CFP — 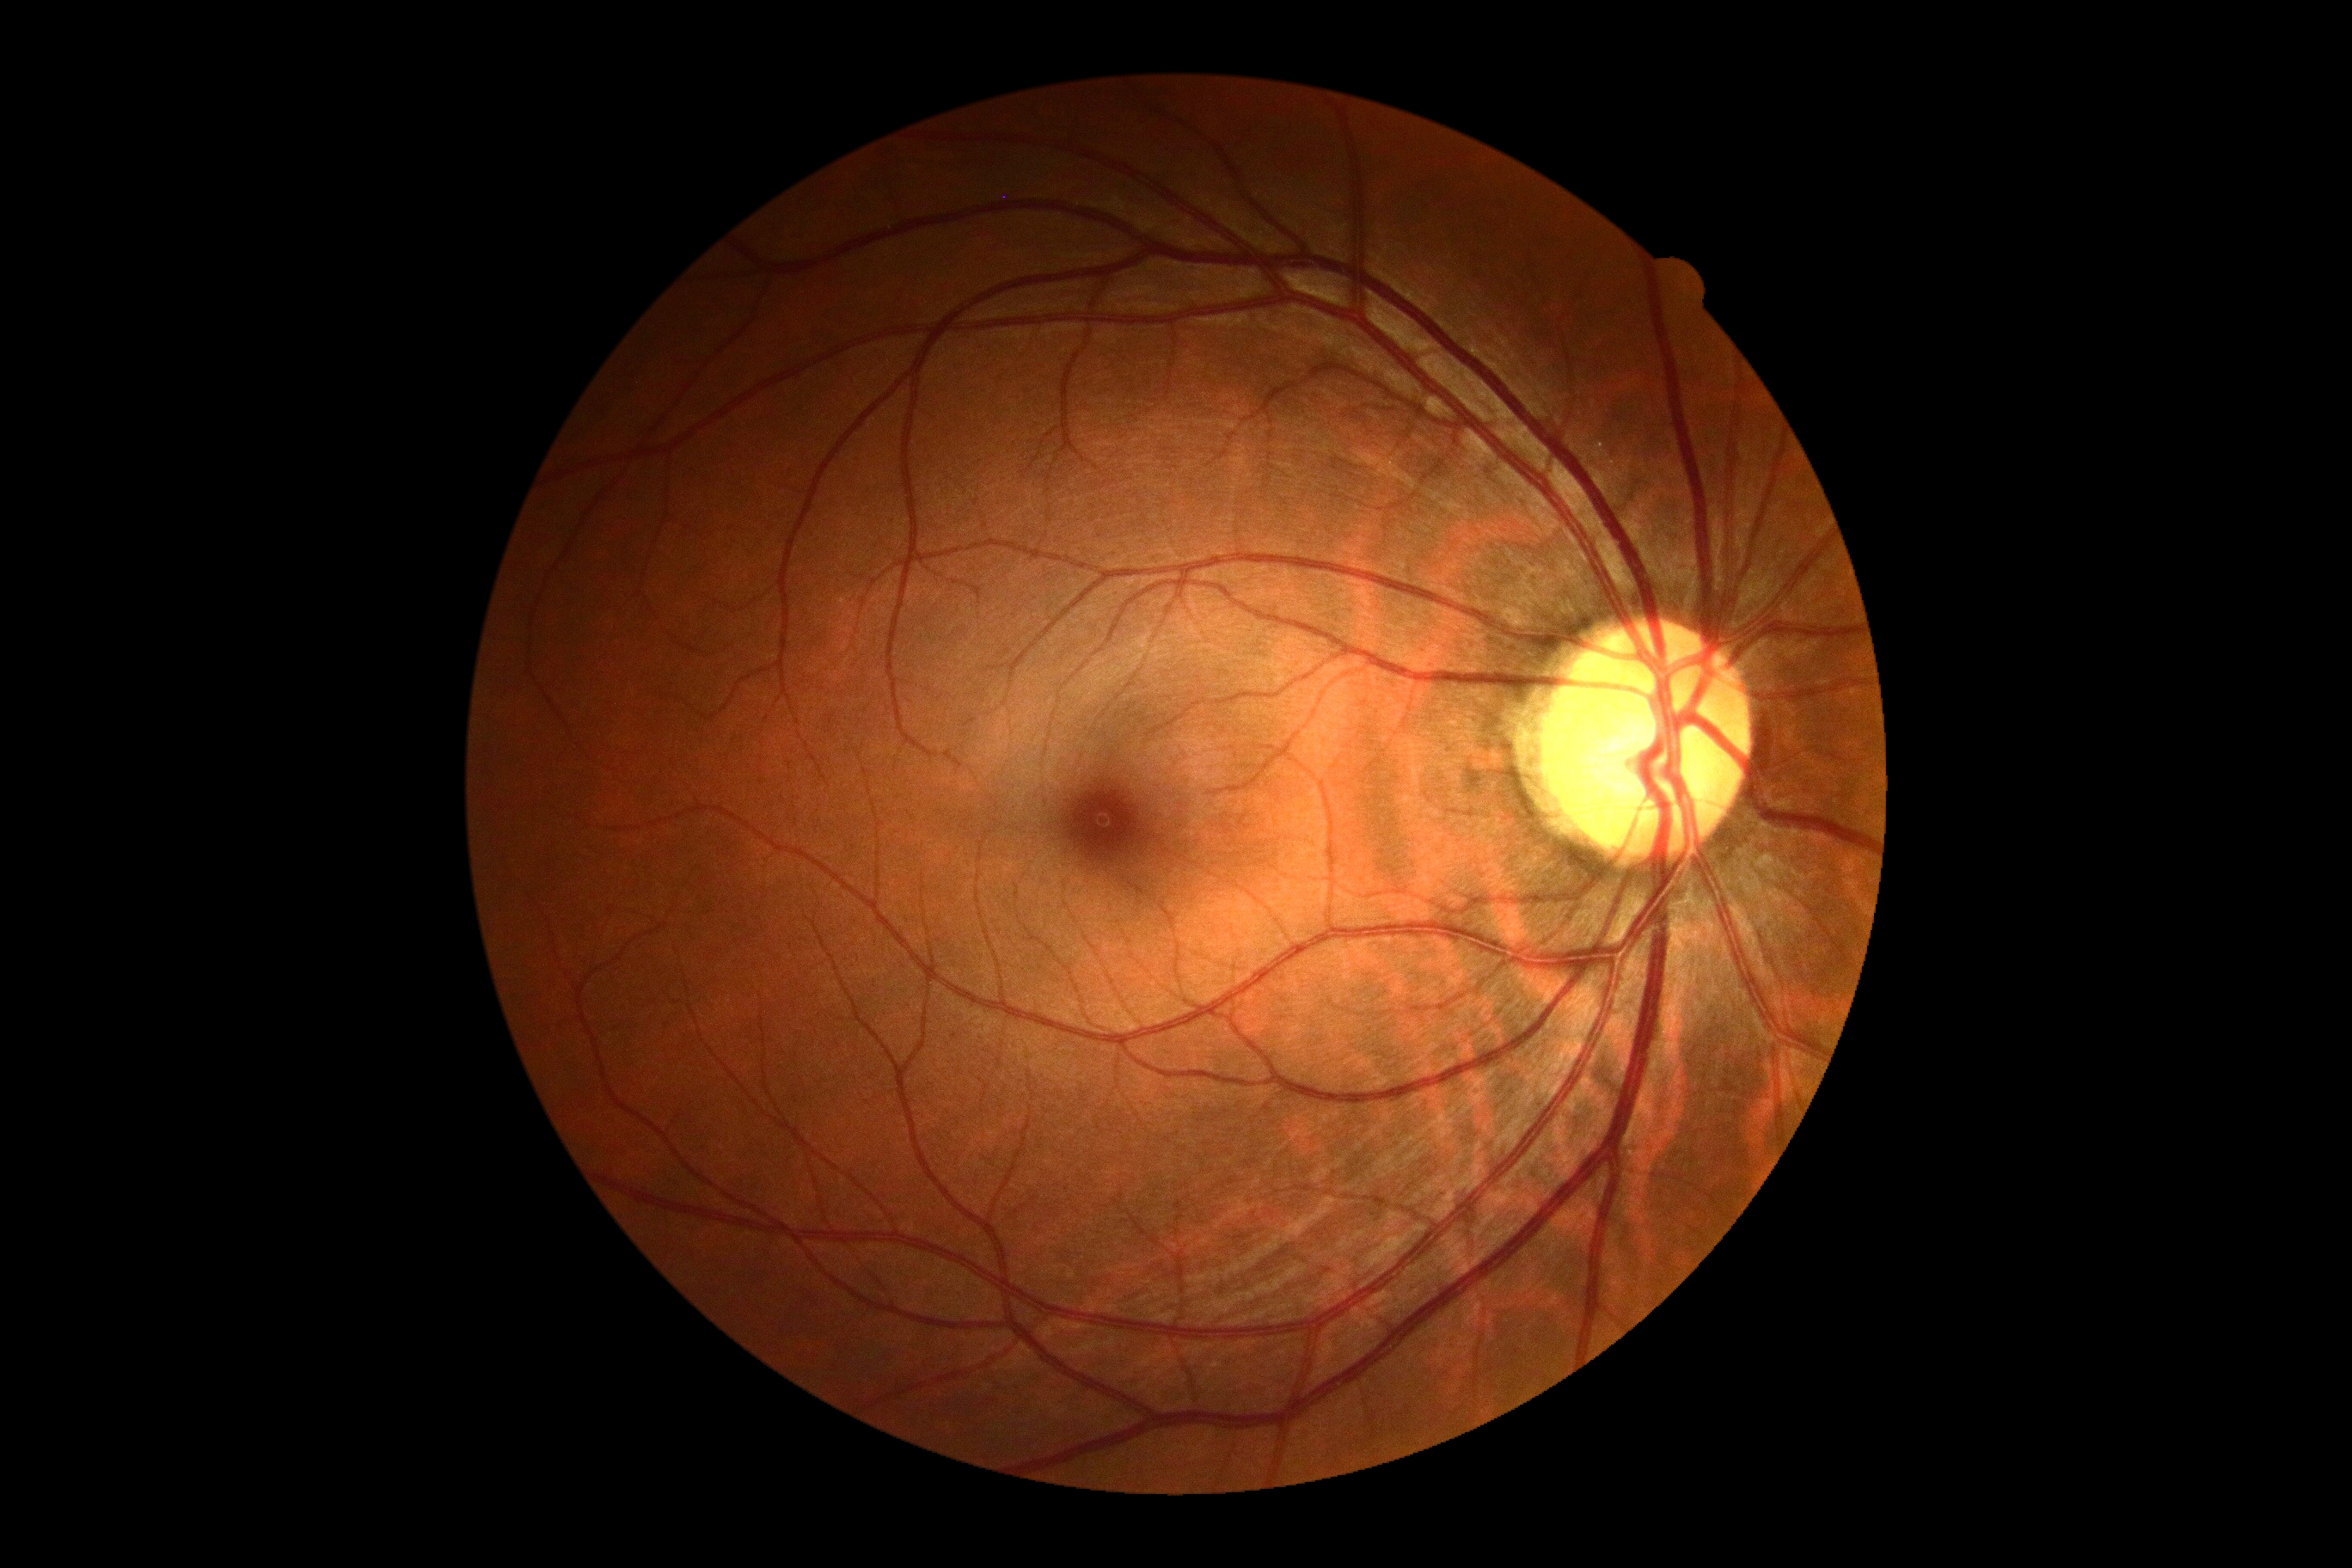
Diabetic retinopathy (DR): grade 0.